FOV: 45 degrees — 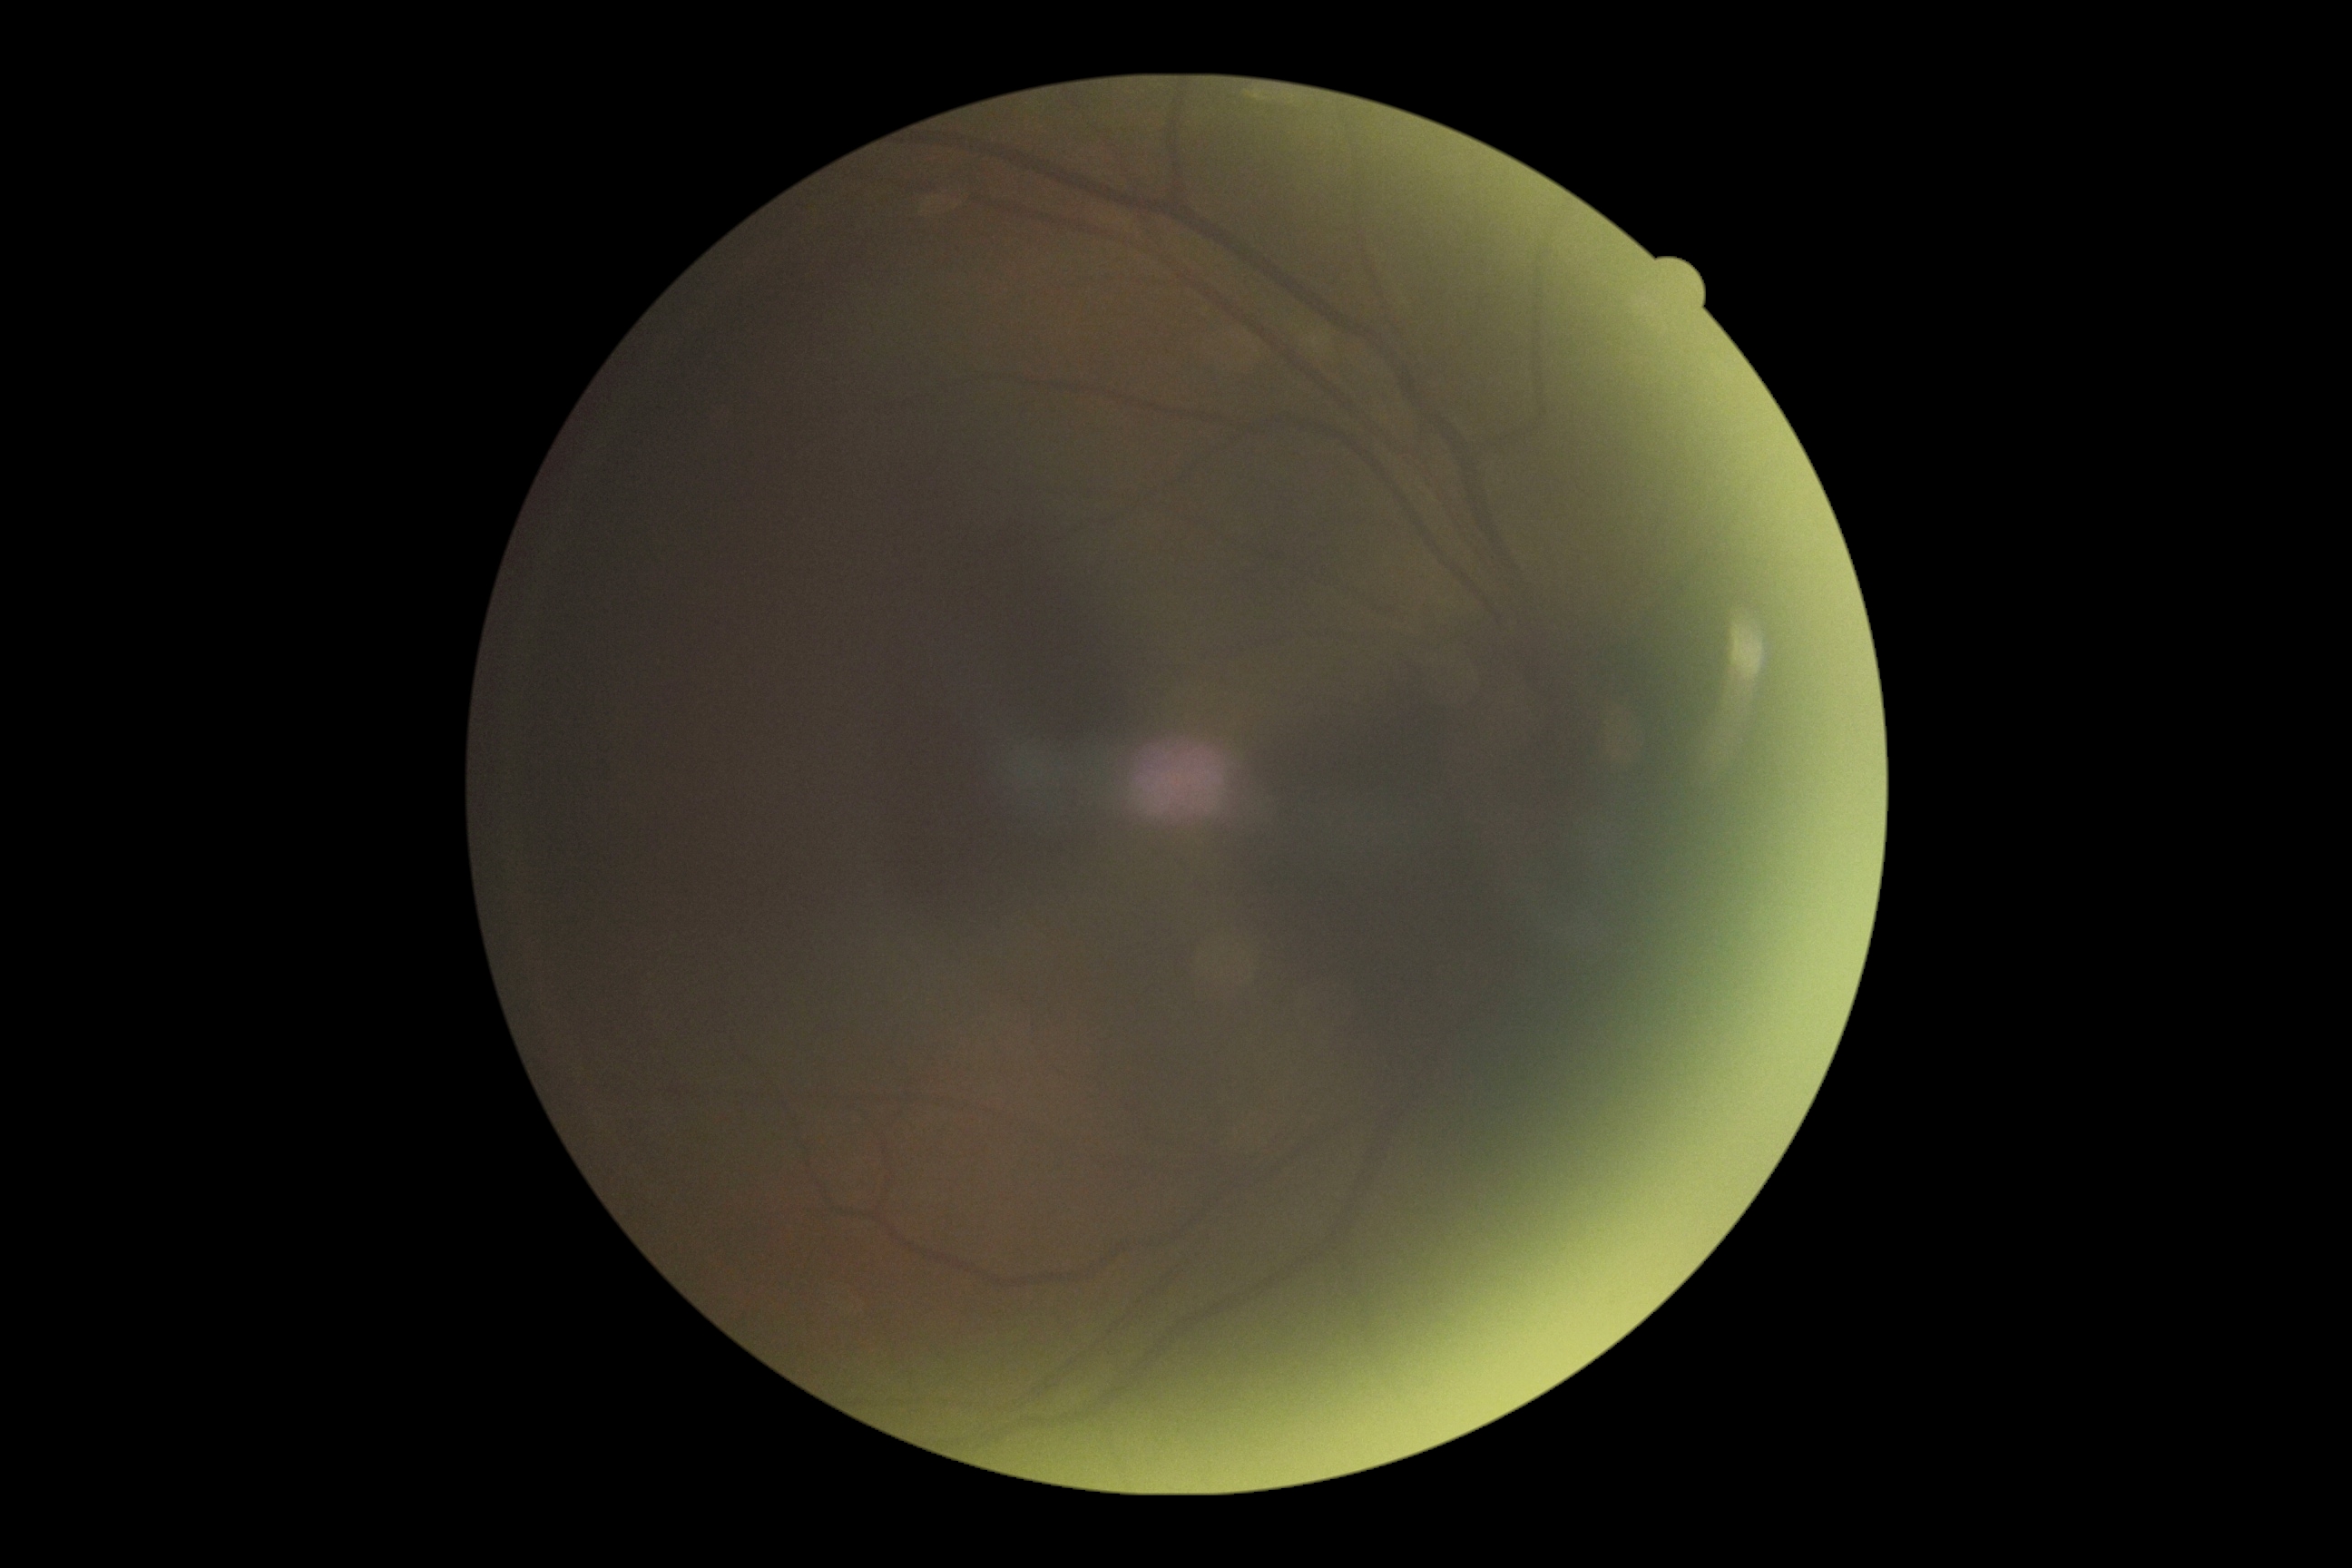

- image quality: below grading threshold
- diabetic retinopathy (DR): ungradable due to poor image quality